Phoenix ICON, 100° FOV. Infant wide-field fundus photograph: 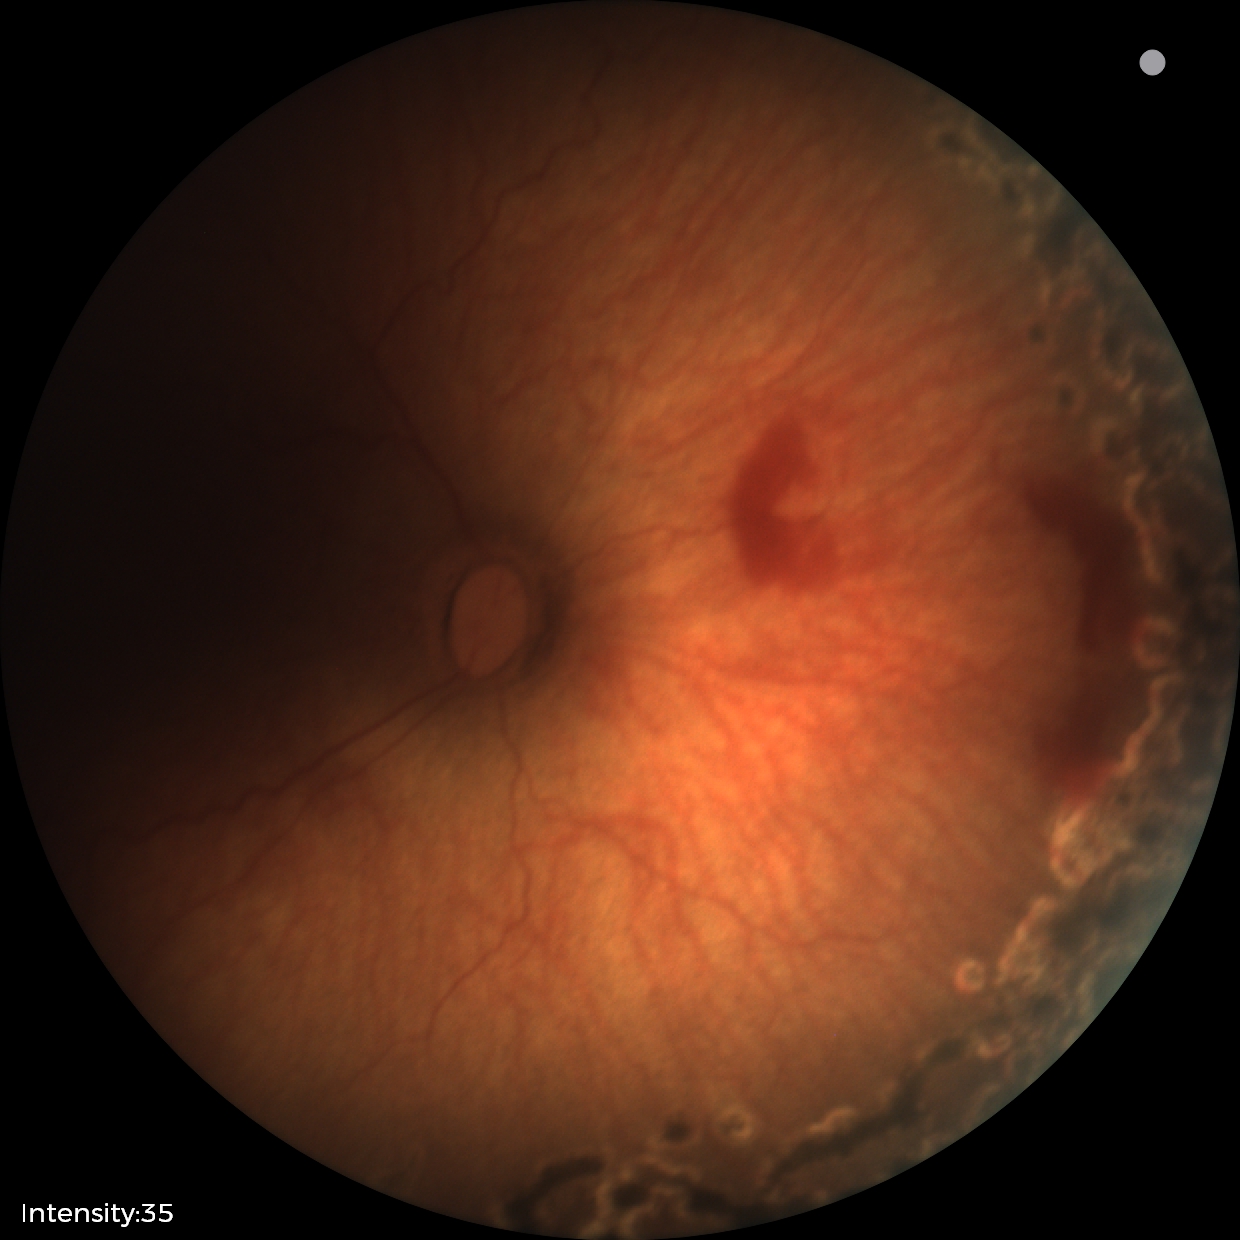 No plus disease.
Series diagnosed as status post ROP.